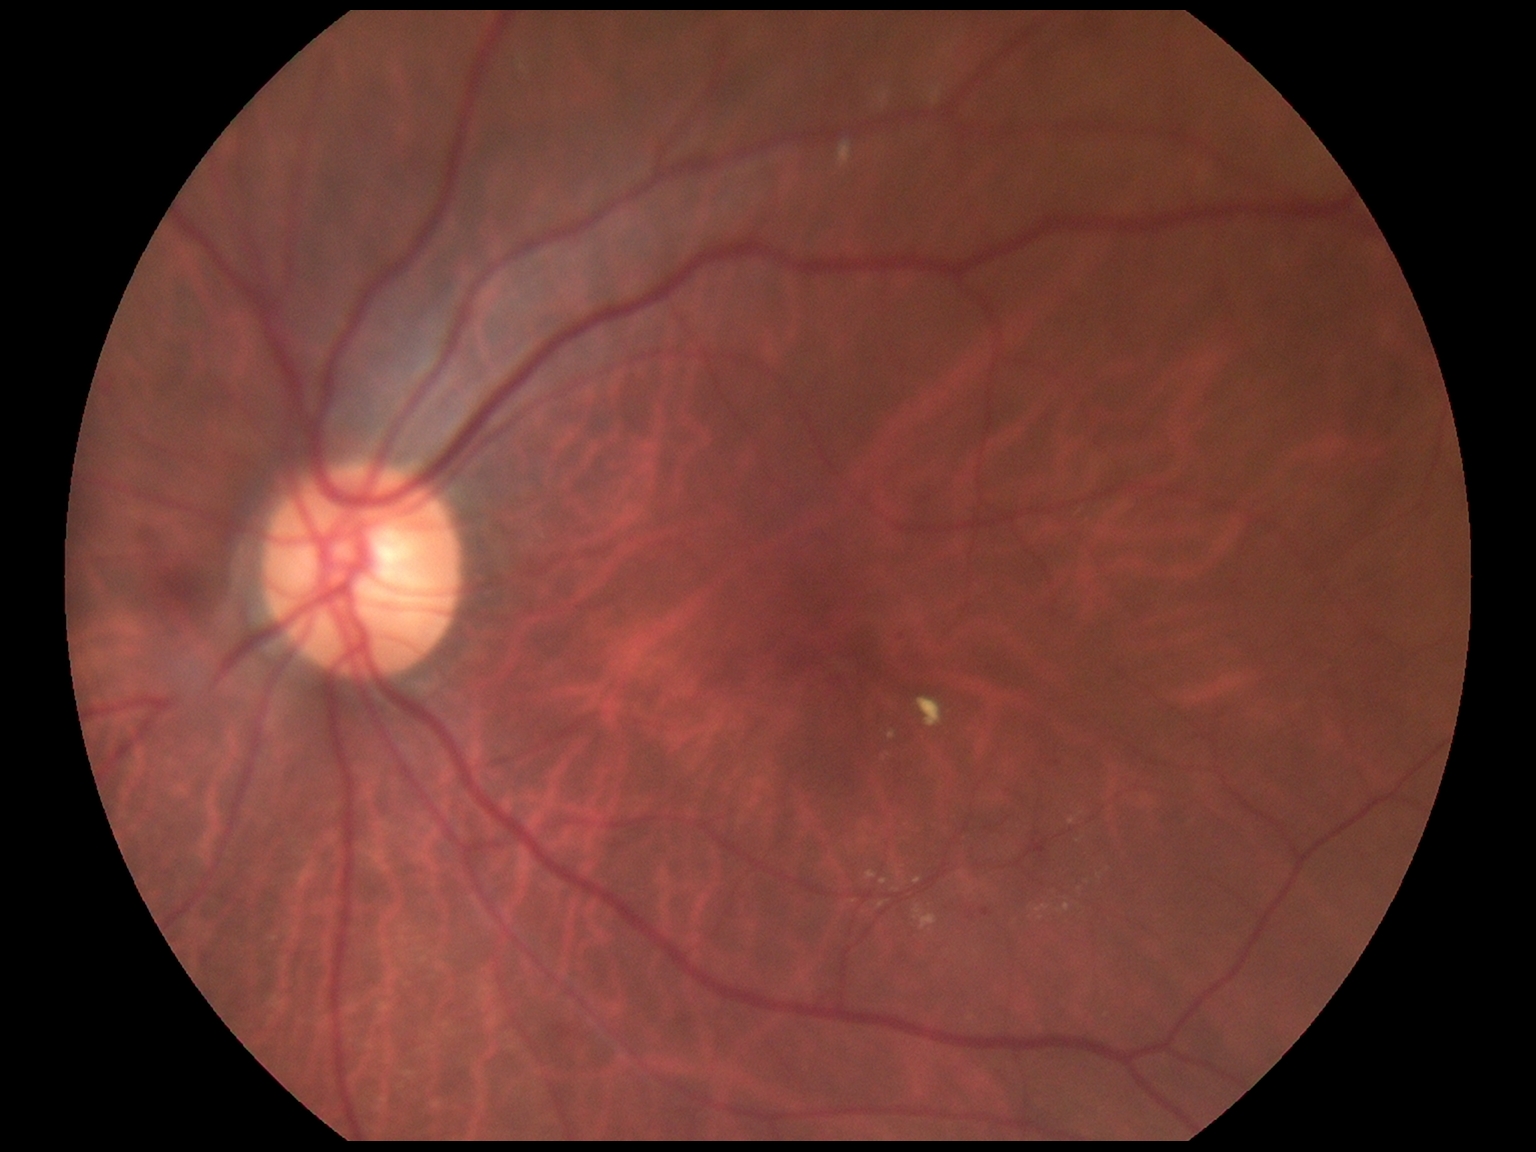
diabetic retinopathy grade: 2 (moderate NPDR) — more than just microaneurysms but less than severe NPDR.